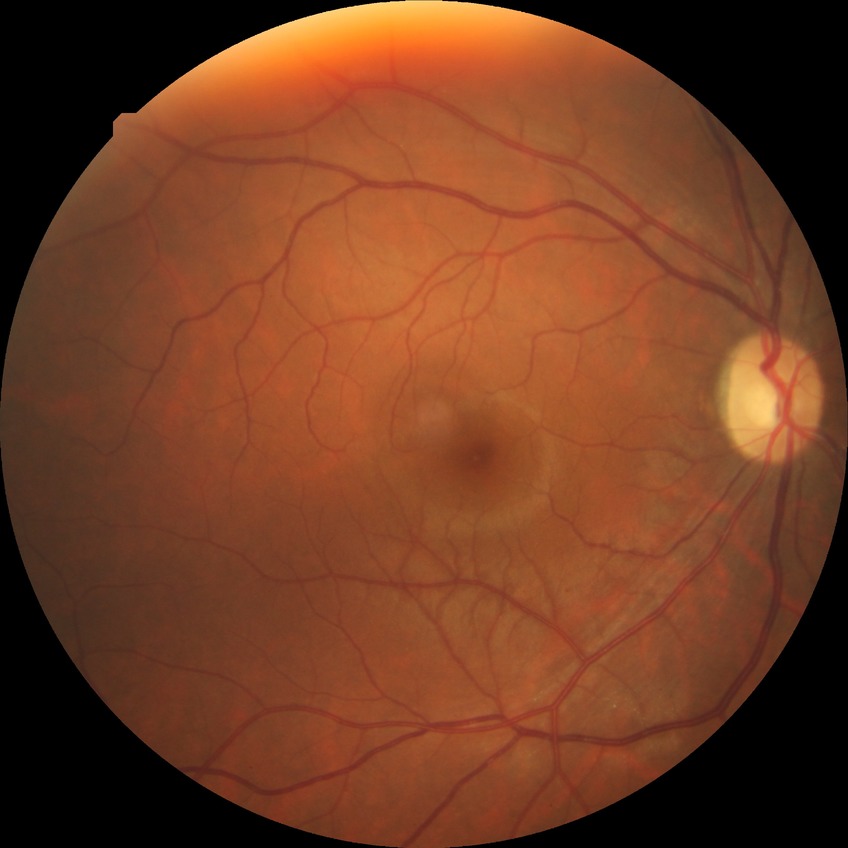
modified Davis grading = no diabetic retinopathy.